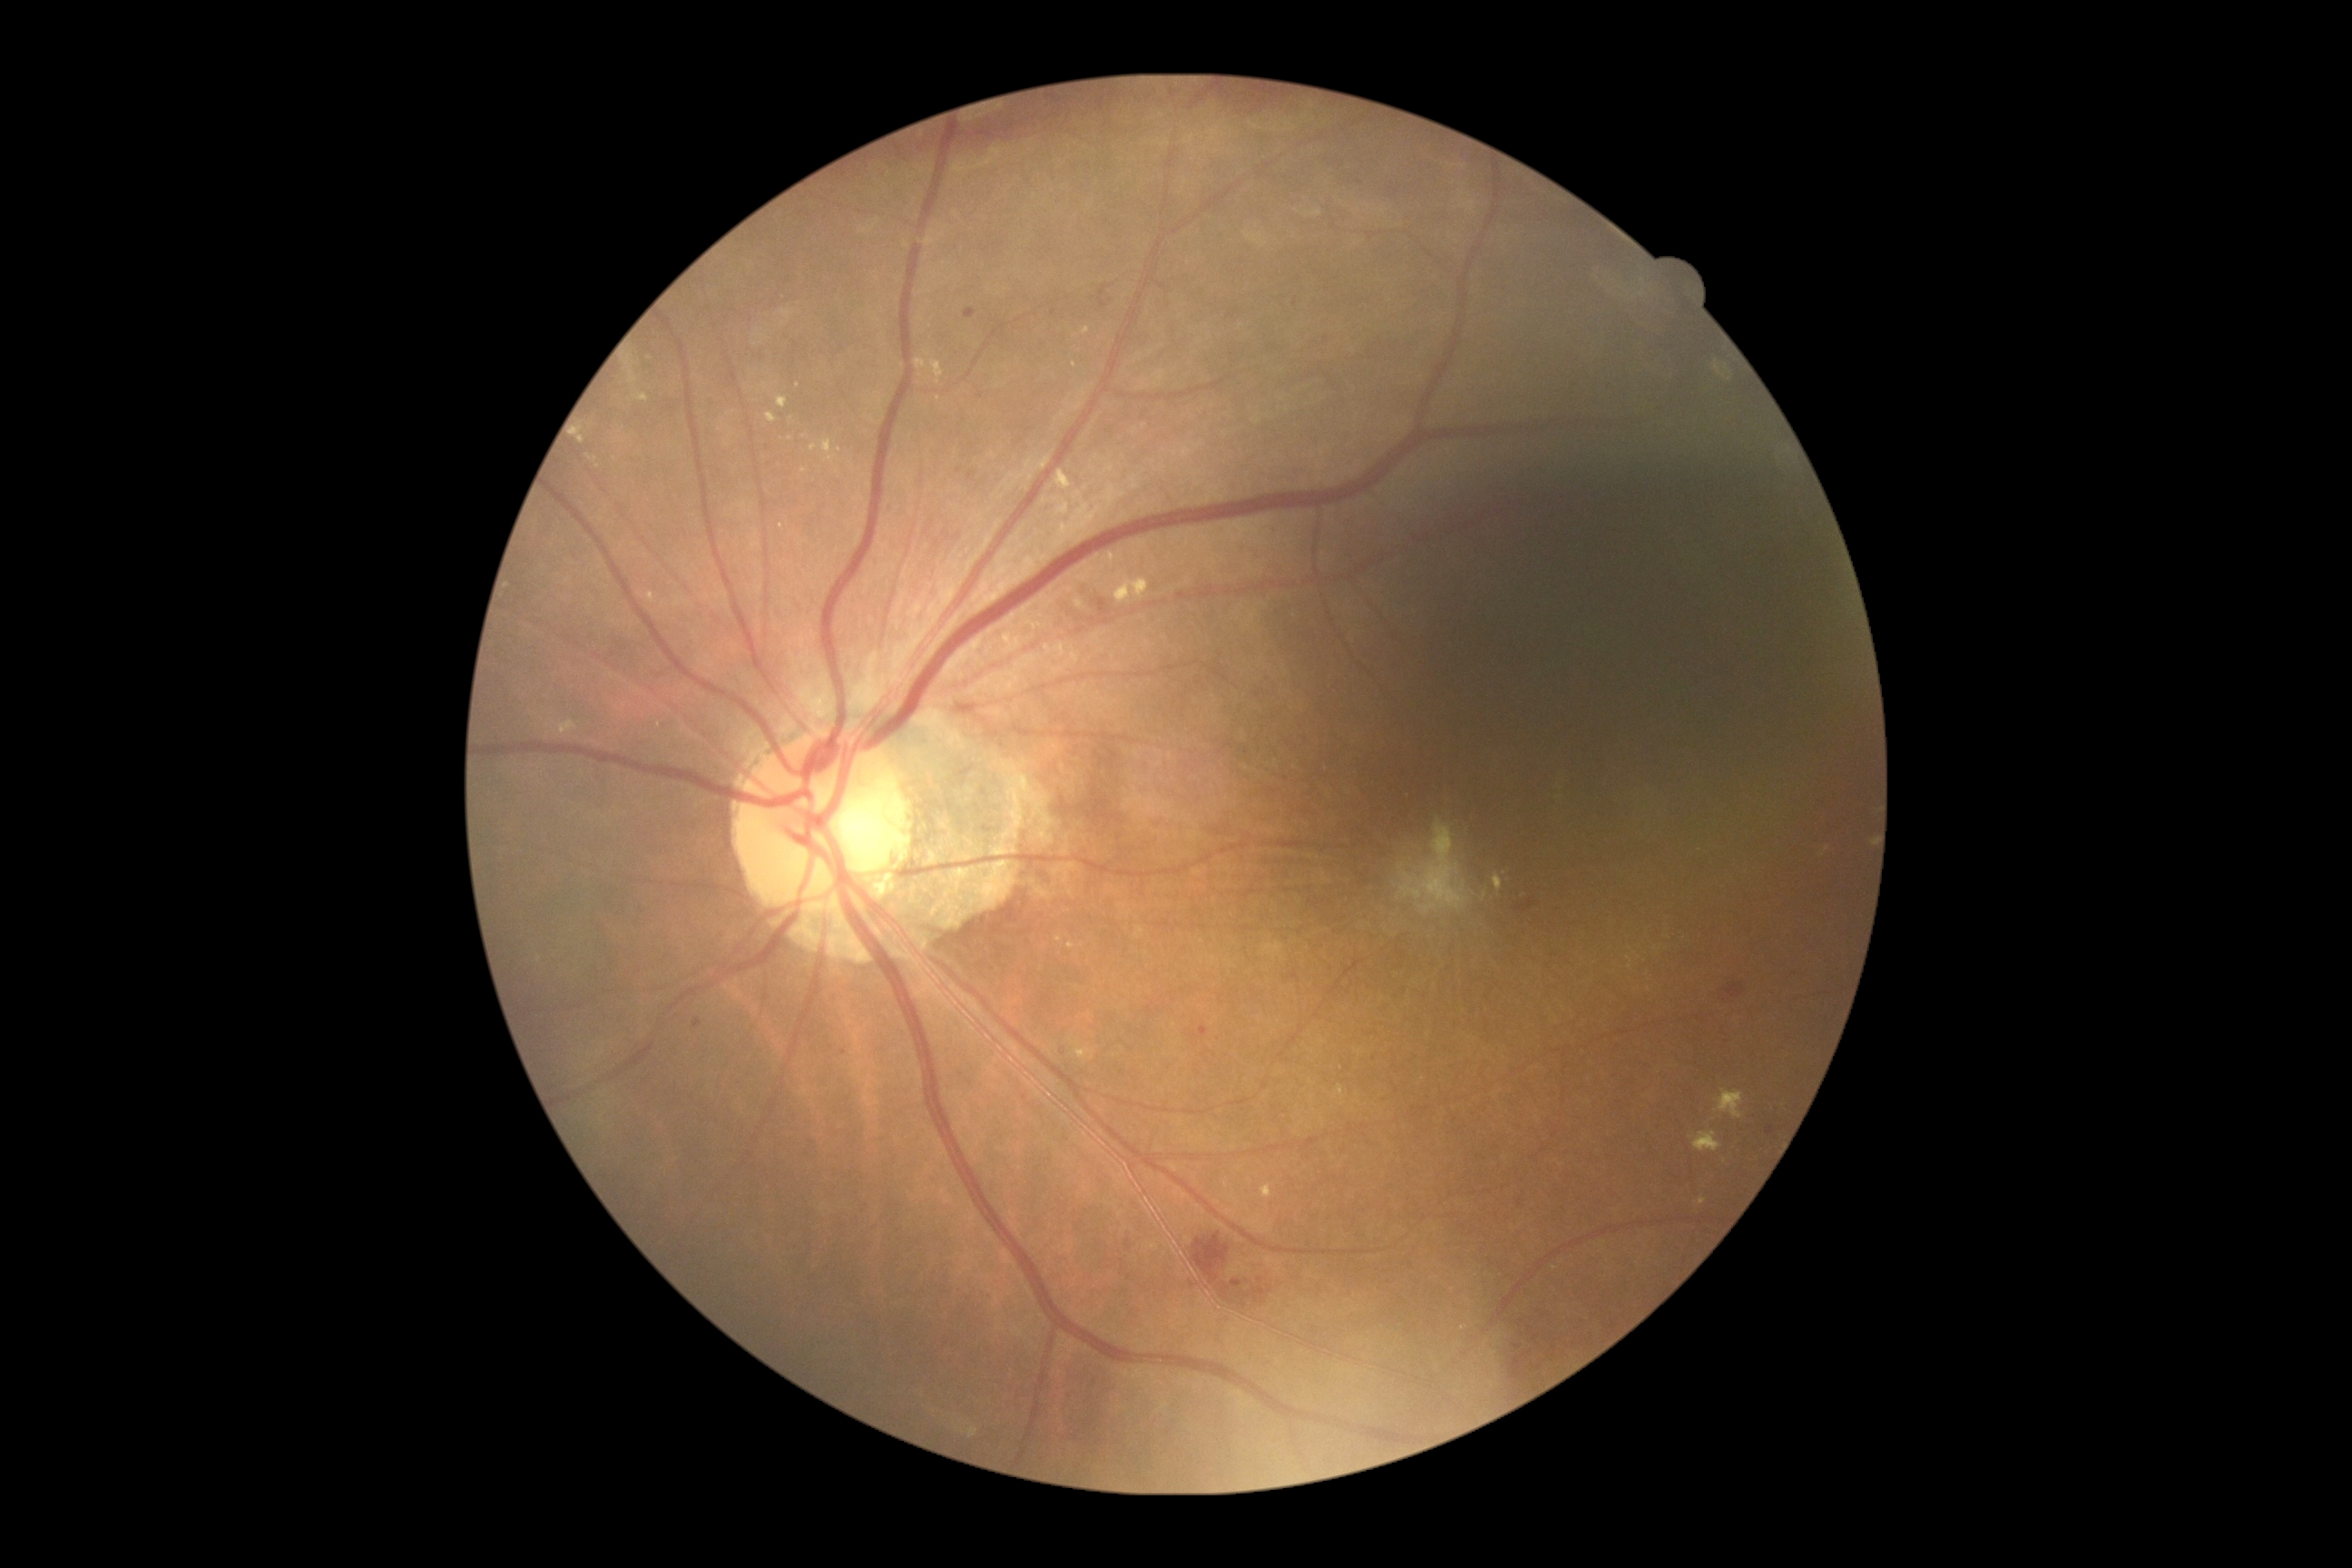
<lesions partial="true">
  <dr_grade>2</dr_grade>
  <ex partial="true">[left=1068, top=651, right=1084, bottom=667], [left=1068, top=598, right=1084, bottom=611], [left=810, top=446, right=818, bottom=453], [left=1494, top=876, right=1504, bottom=892], [left=634, top=393, right=649, bottom=402], [left=558, top=720, right=578, bottom=736], [left=821, top=440, right=838, bottom=464], [left=1821, top=847, right=1830, bottom=856], [left=1716, top=1090, right=1745, bottom=1121], [left=576, top=426, right=585, bottom=446]</ex>
  <ex_small_approx>[x=852, y=465], [x=765, y=386], [x=1074, y=365], [x=840, y=450]</ex_small_approx>
</lesions>